45-degree field of view, 2350x1568px, color fundus image — 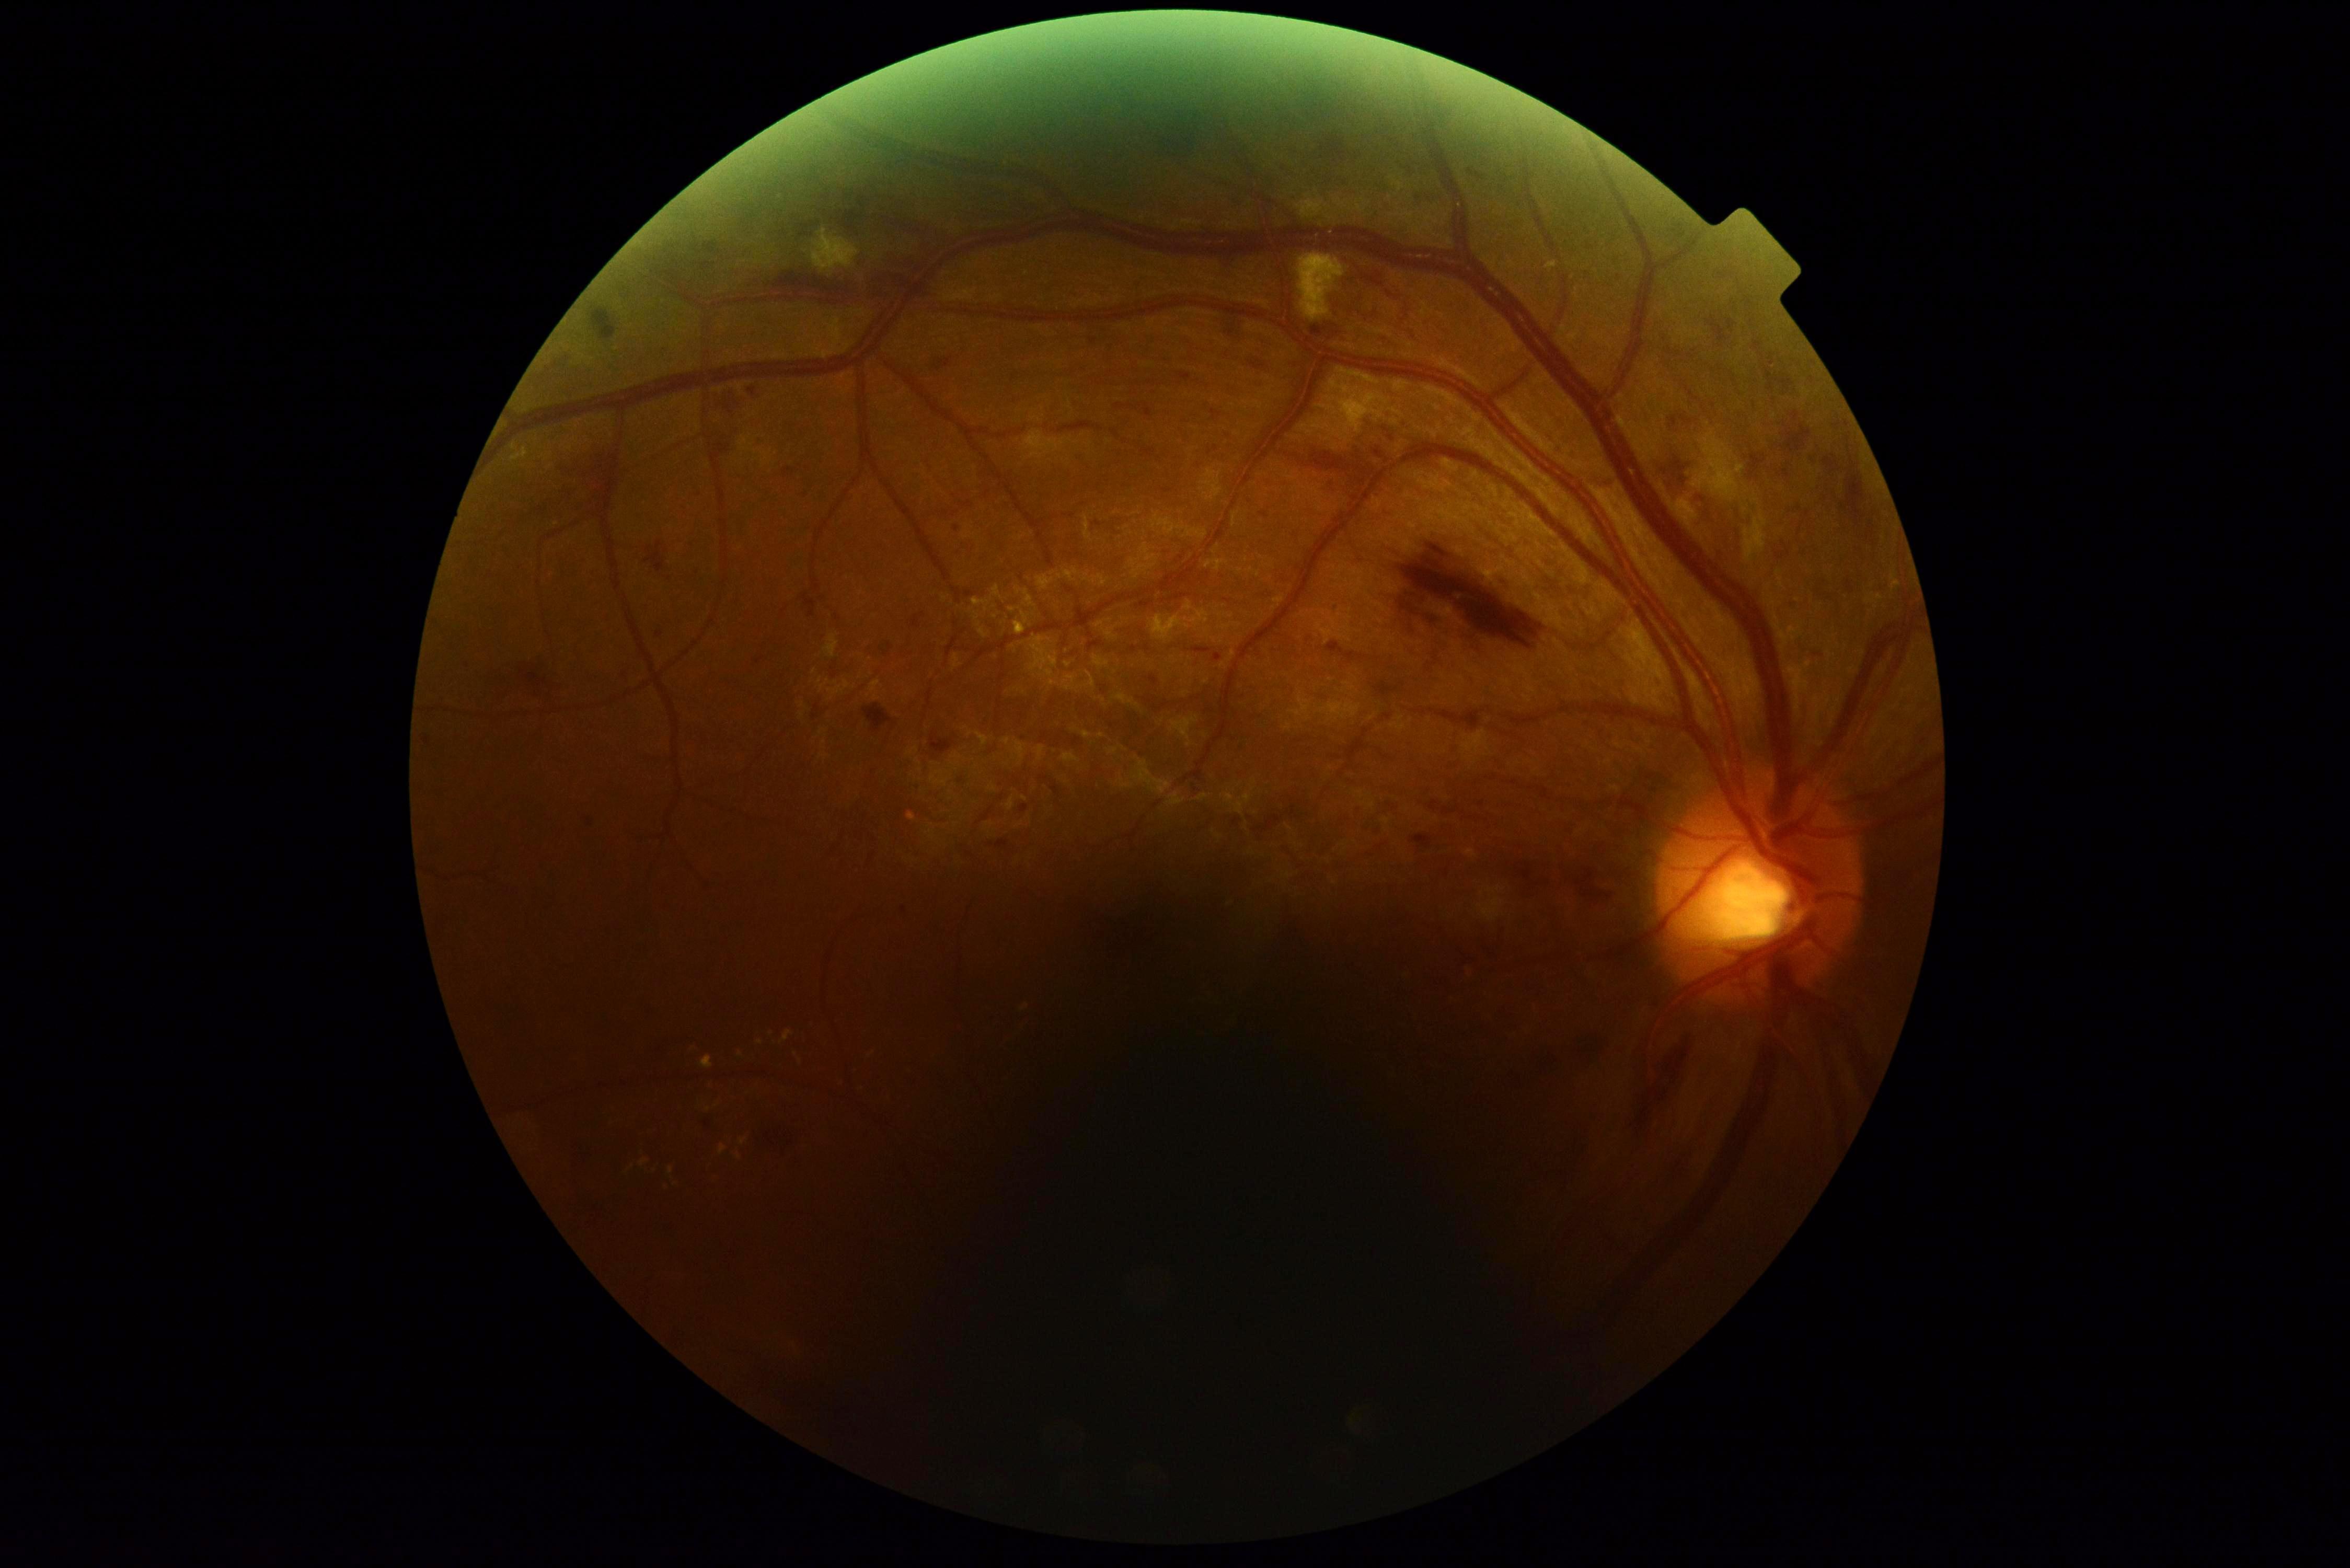

DR class: non-proliferative diabetic retinopathy. Diabetic retinopathy: moderate non-proliferative diabetic retinopathy (grade 2).